848 by 848 pixels: 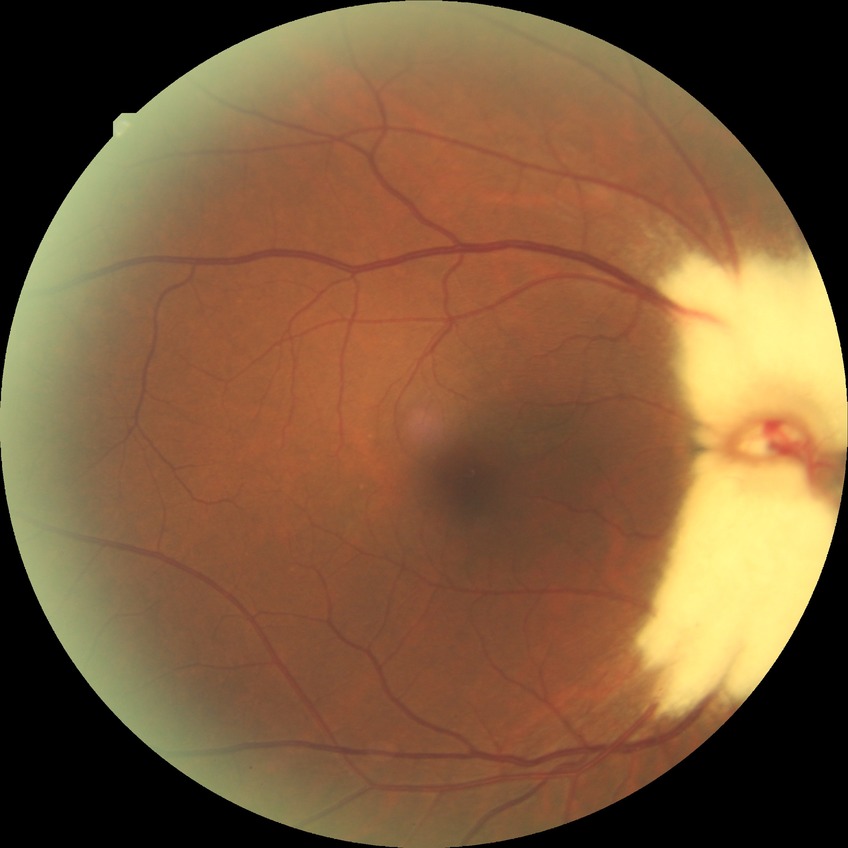
modified Davis grading: no diabetic retinopathy.